Wide-field fundus image from infant ROP screening. Captured with the Natus RetCam Envision (130° field of view). 1440 x 1080 pixels.
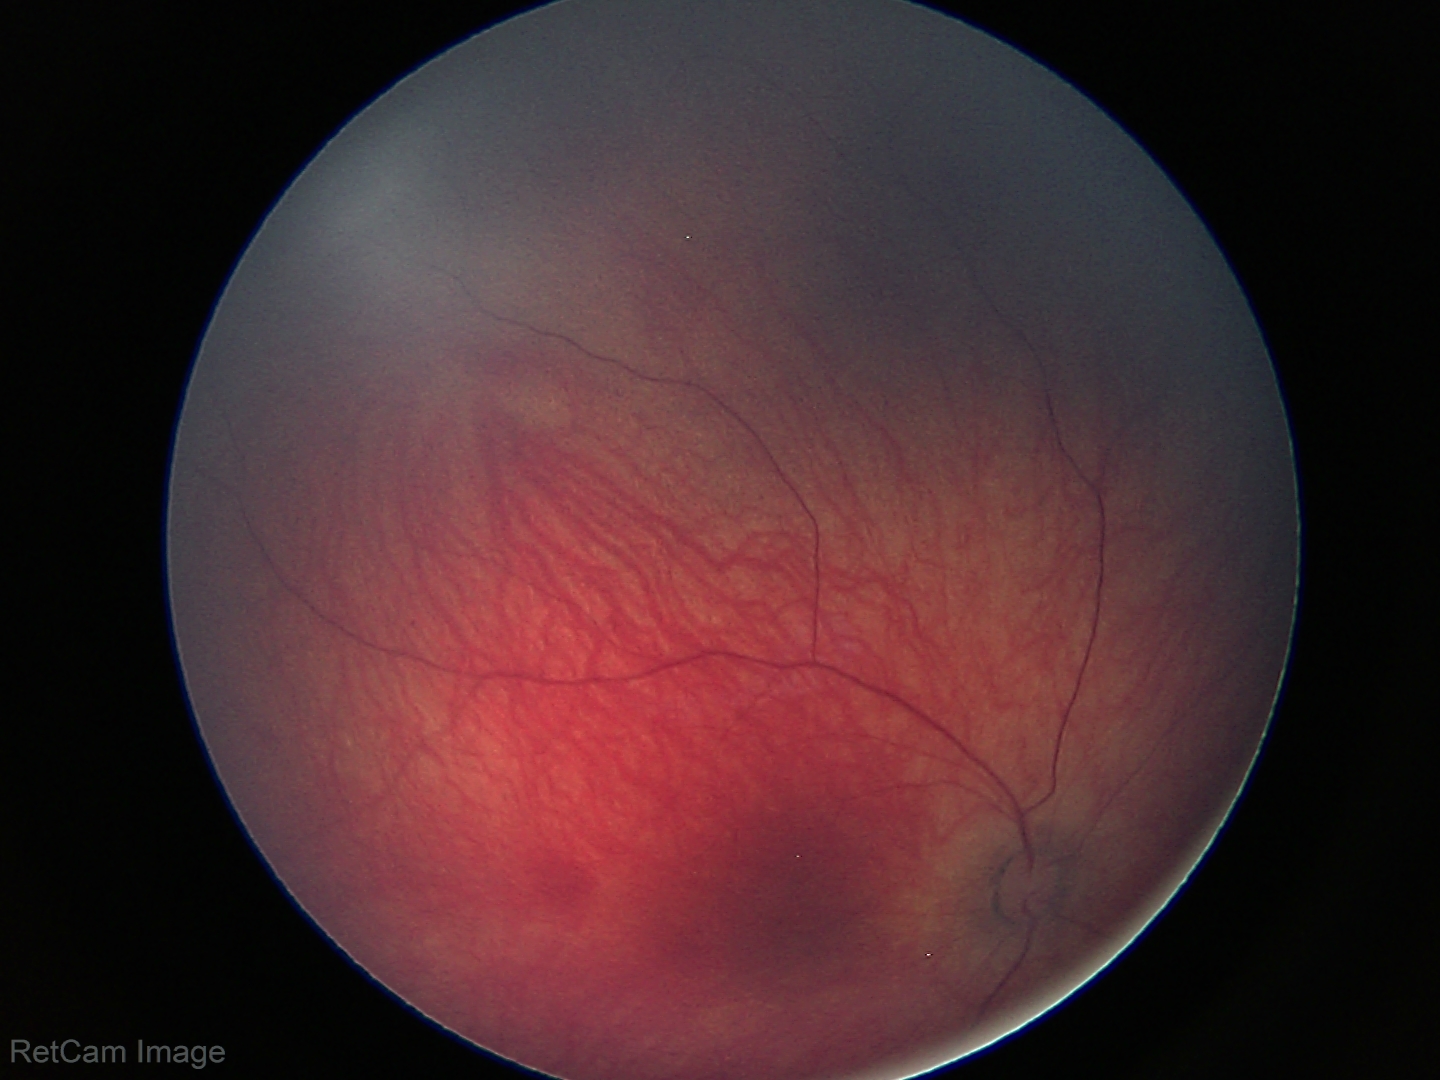

Screening diagnosis: physiological.